Phoenix ICON wide-field infant fundus image; captured with the Phoenix ICON (100° field of view) — 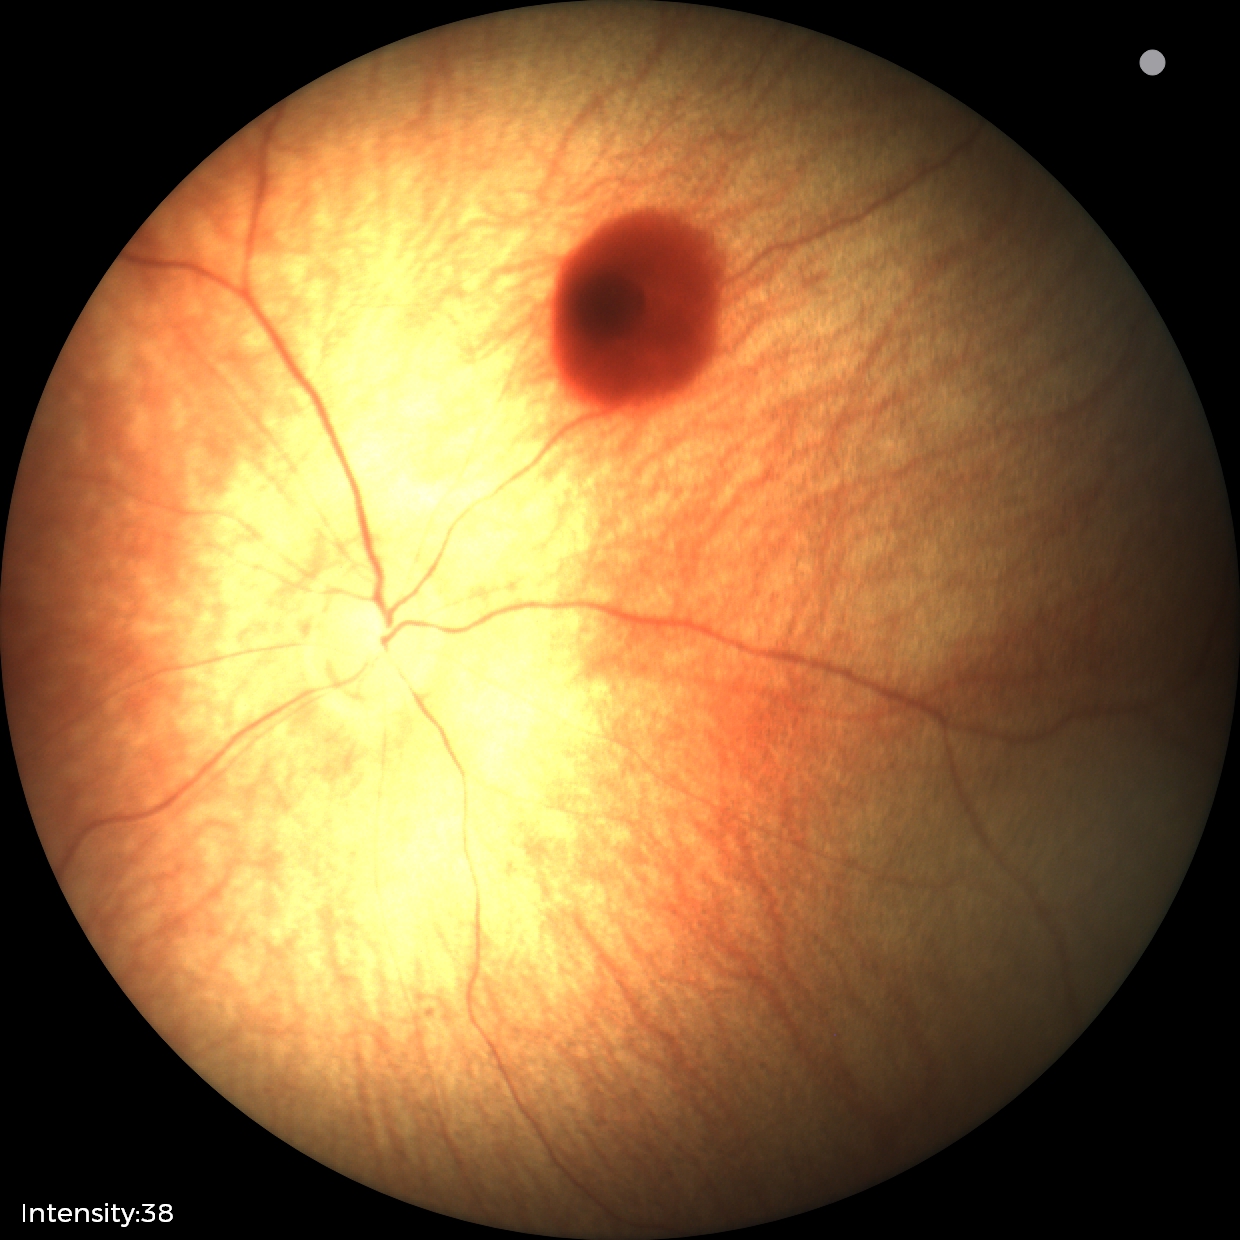
From an examination with diagnosis of retinal hemorrhages.